Pediatric retinal photograph (wide-field). Phoenix ICON, 100° FOV.
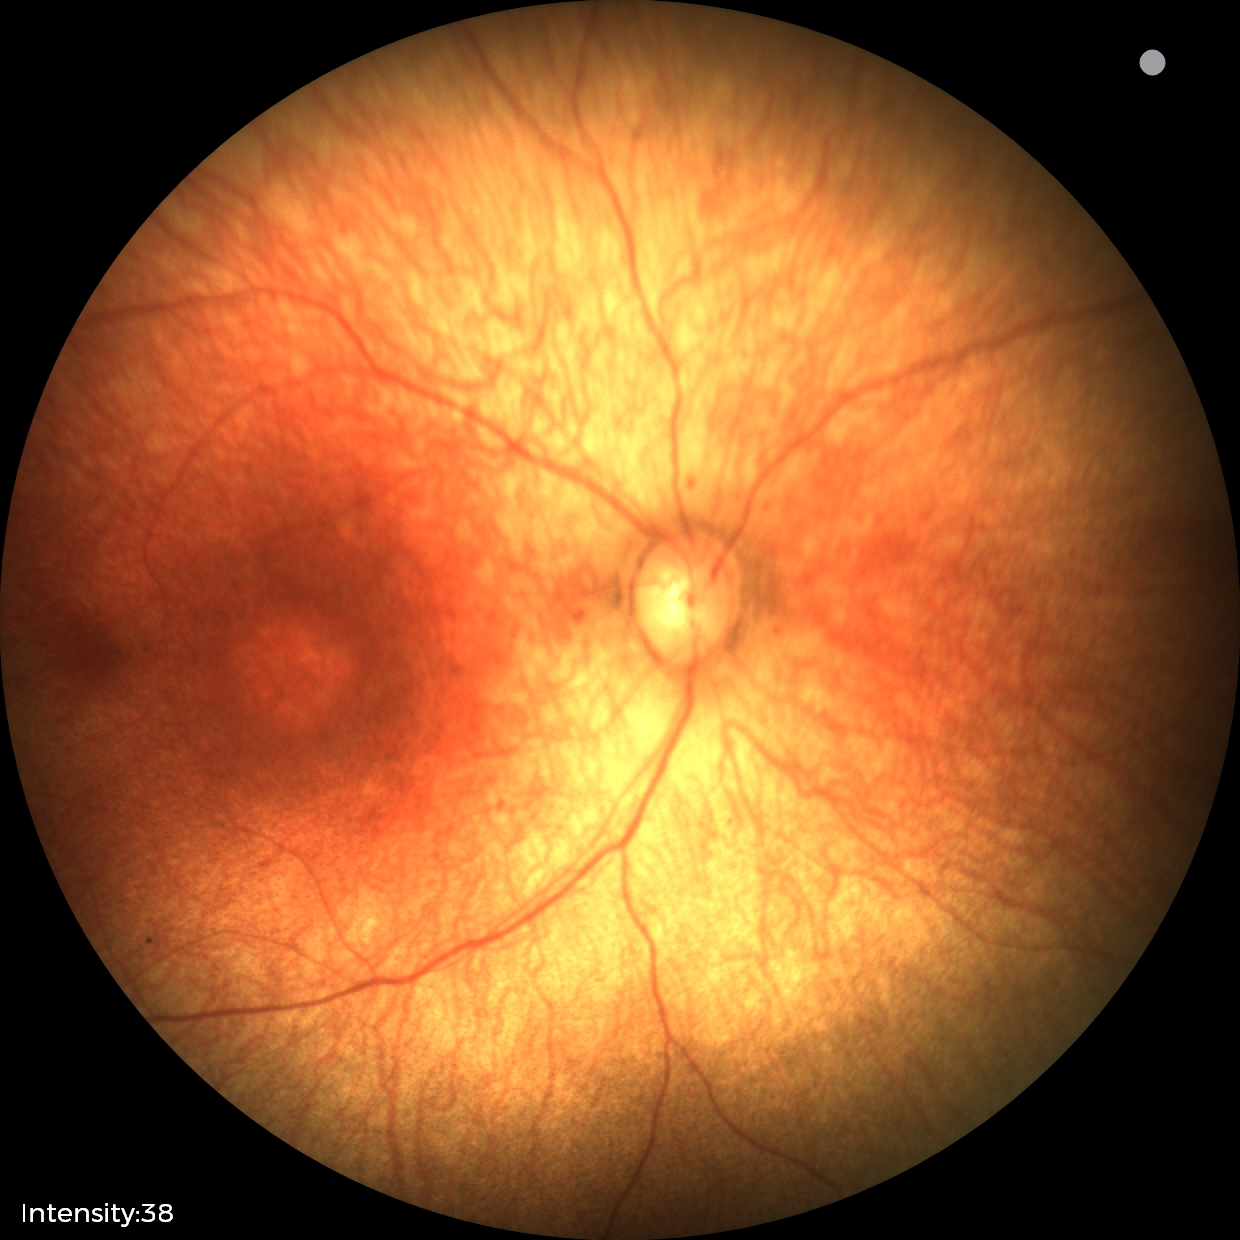
Physiological retinal appearance for postconceptual age.